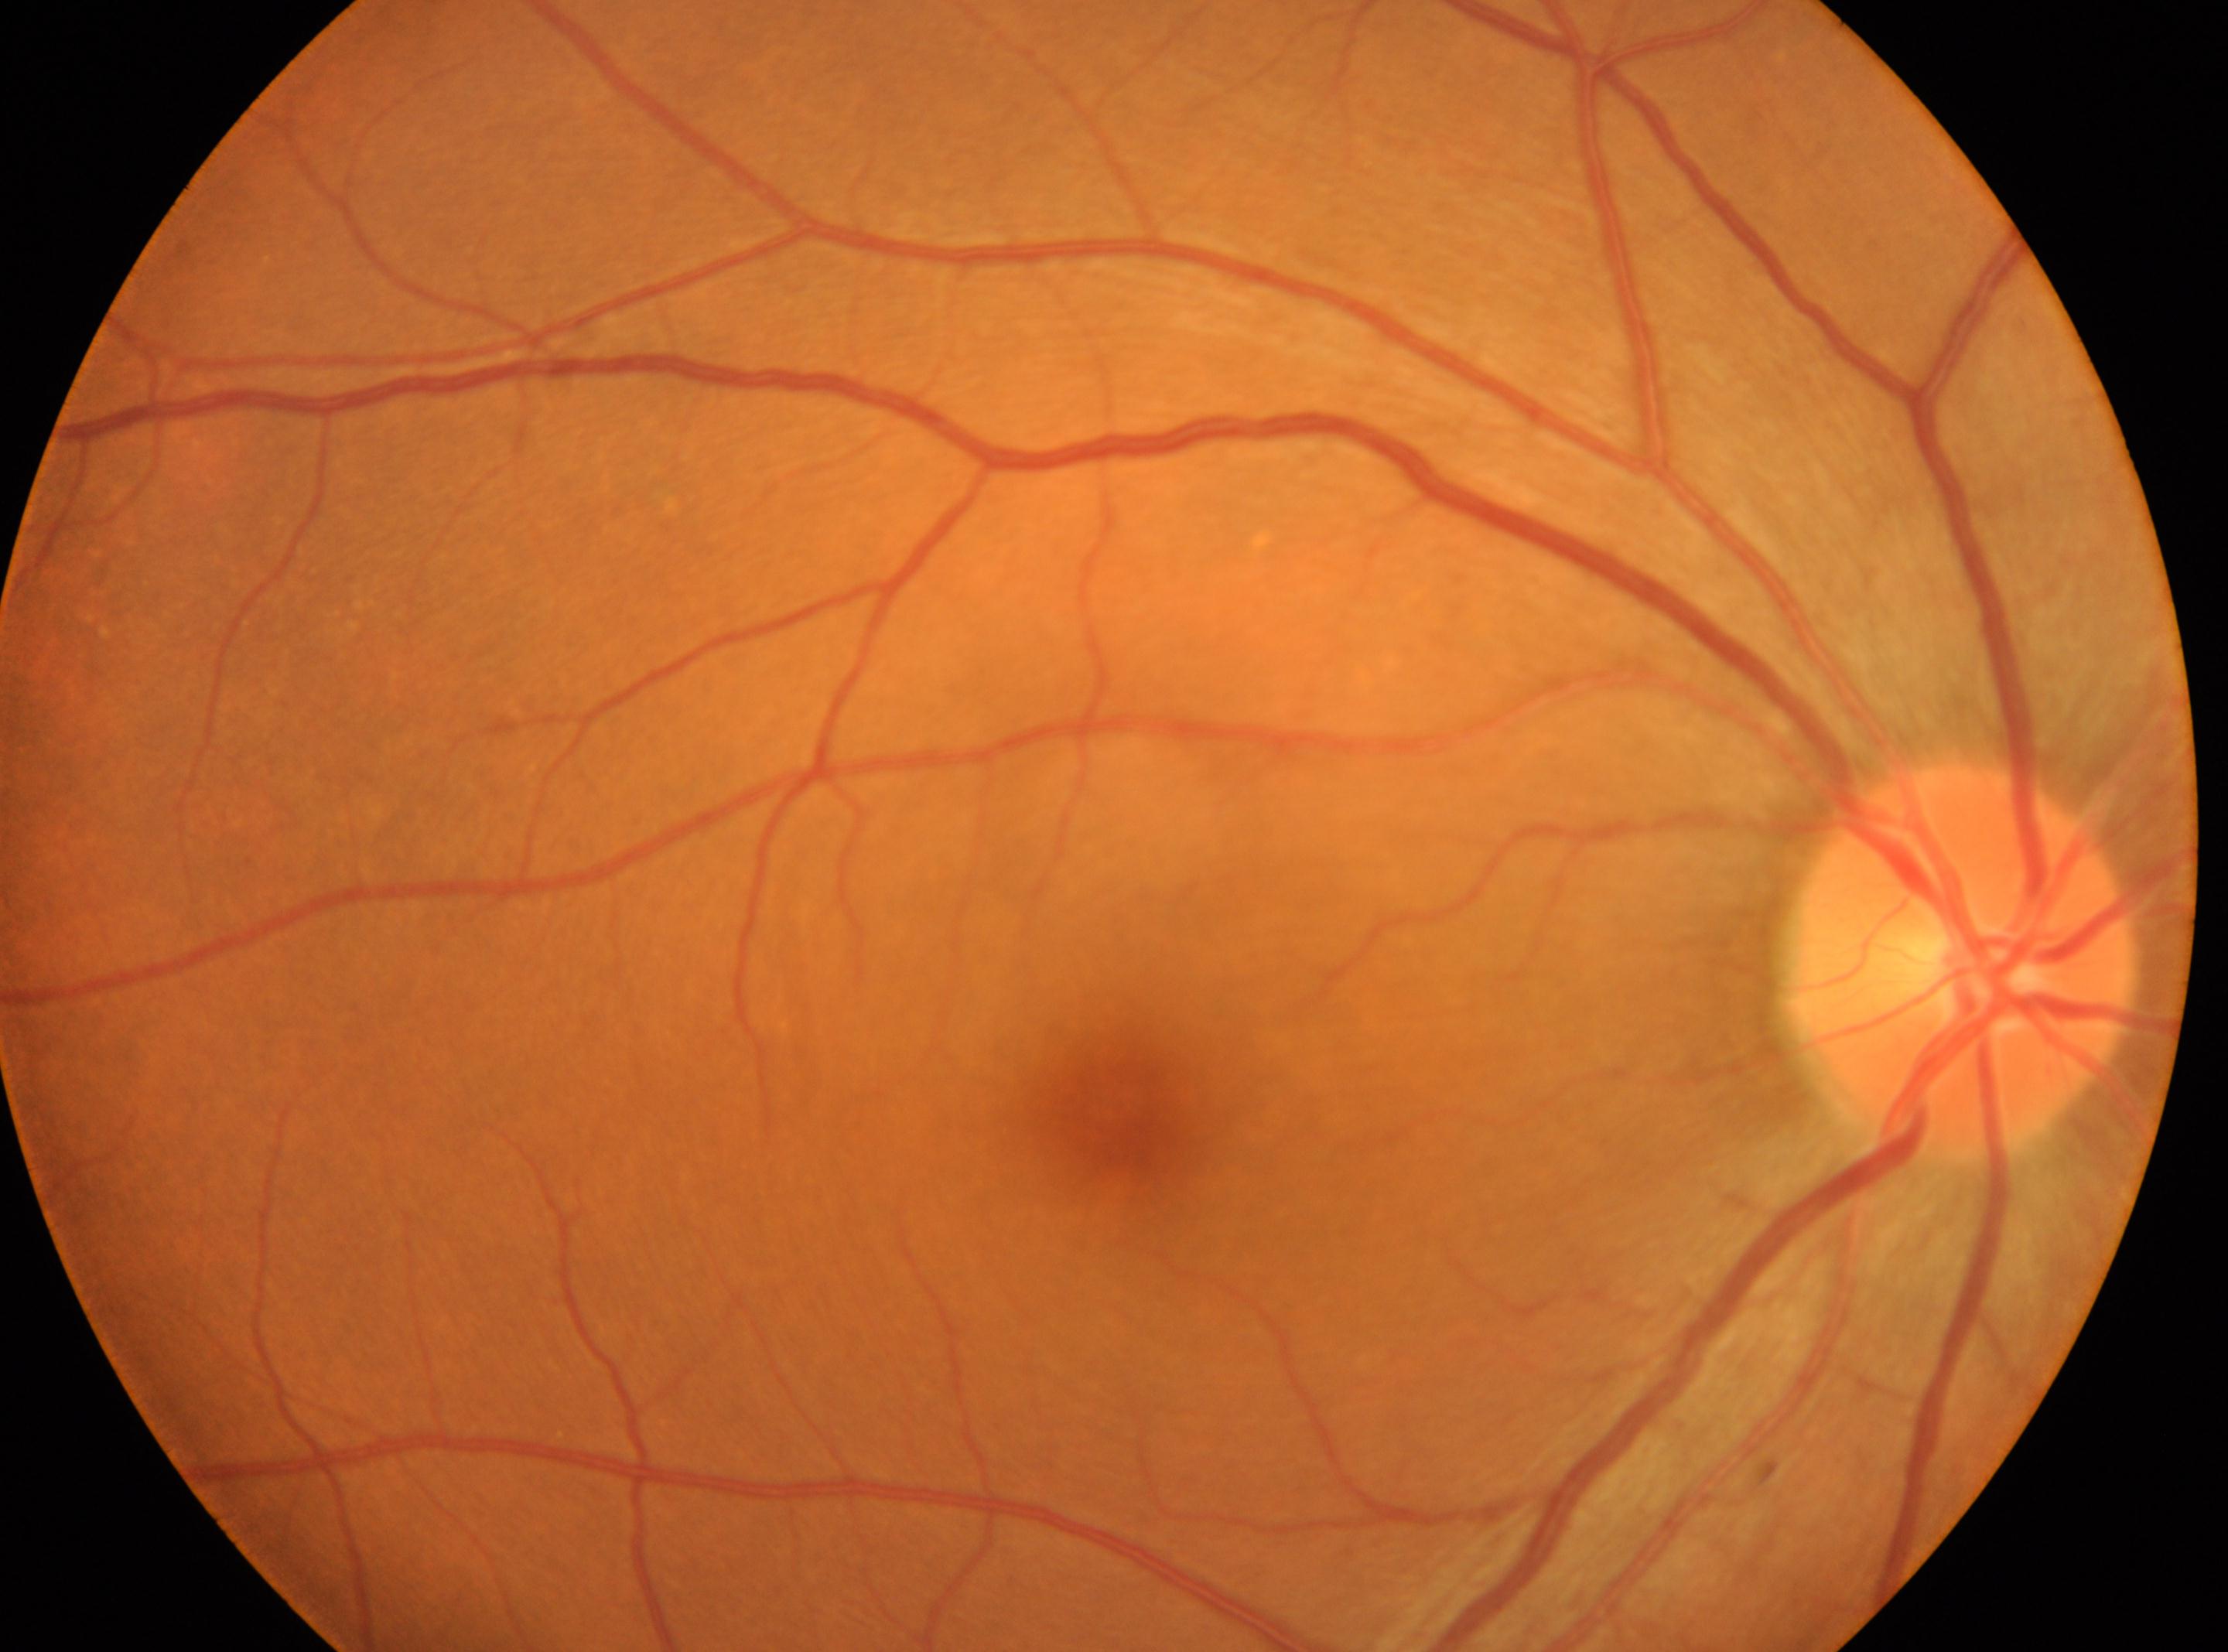
Q: Locate the fovea.
A: (x=1116, y=1108)
Q: Locate the optic disc.
A: (x=1960, y=957)
Q: Which eye is imaged?
A: oculus dexter
Q: DR stage?
A: no apparent diabetic retinopathy (grade 0)